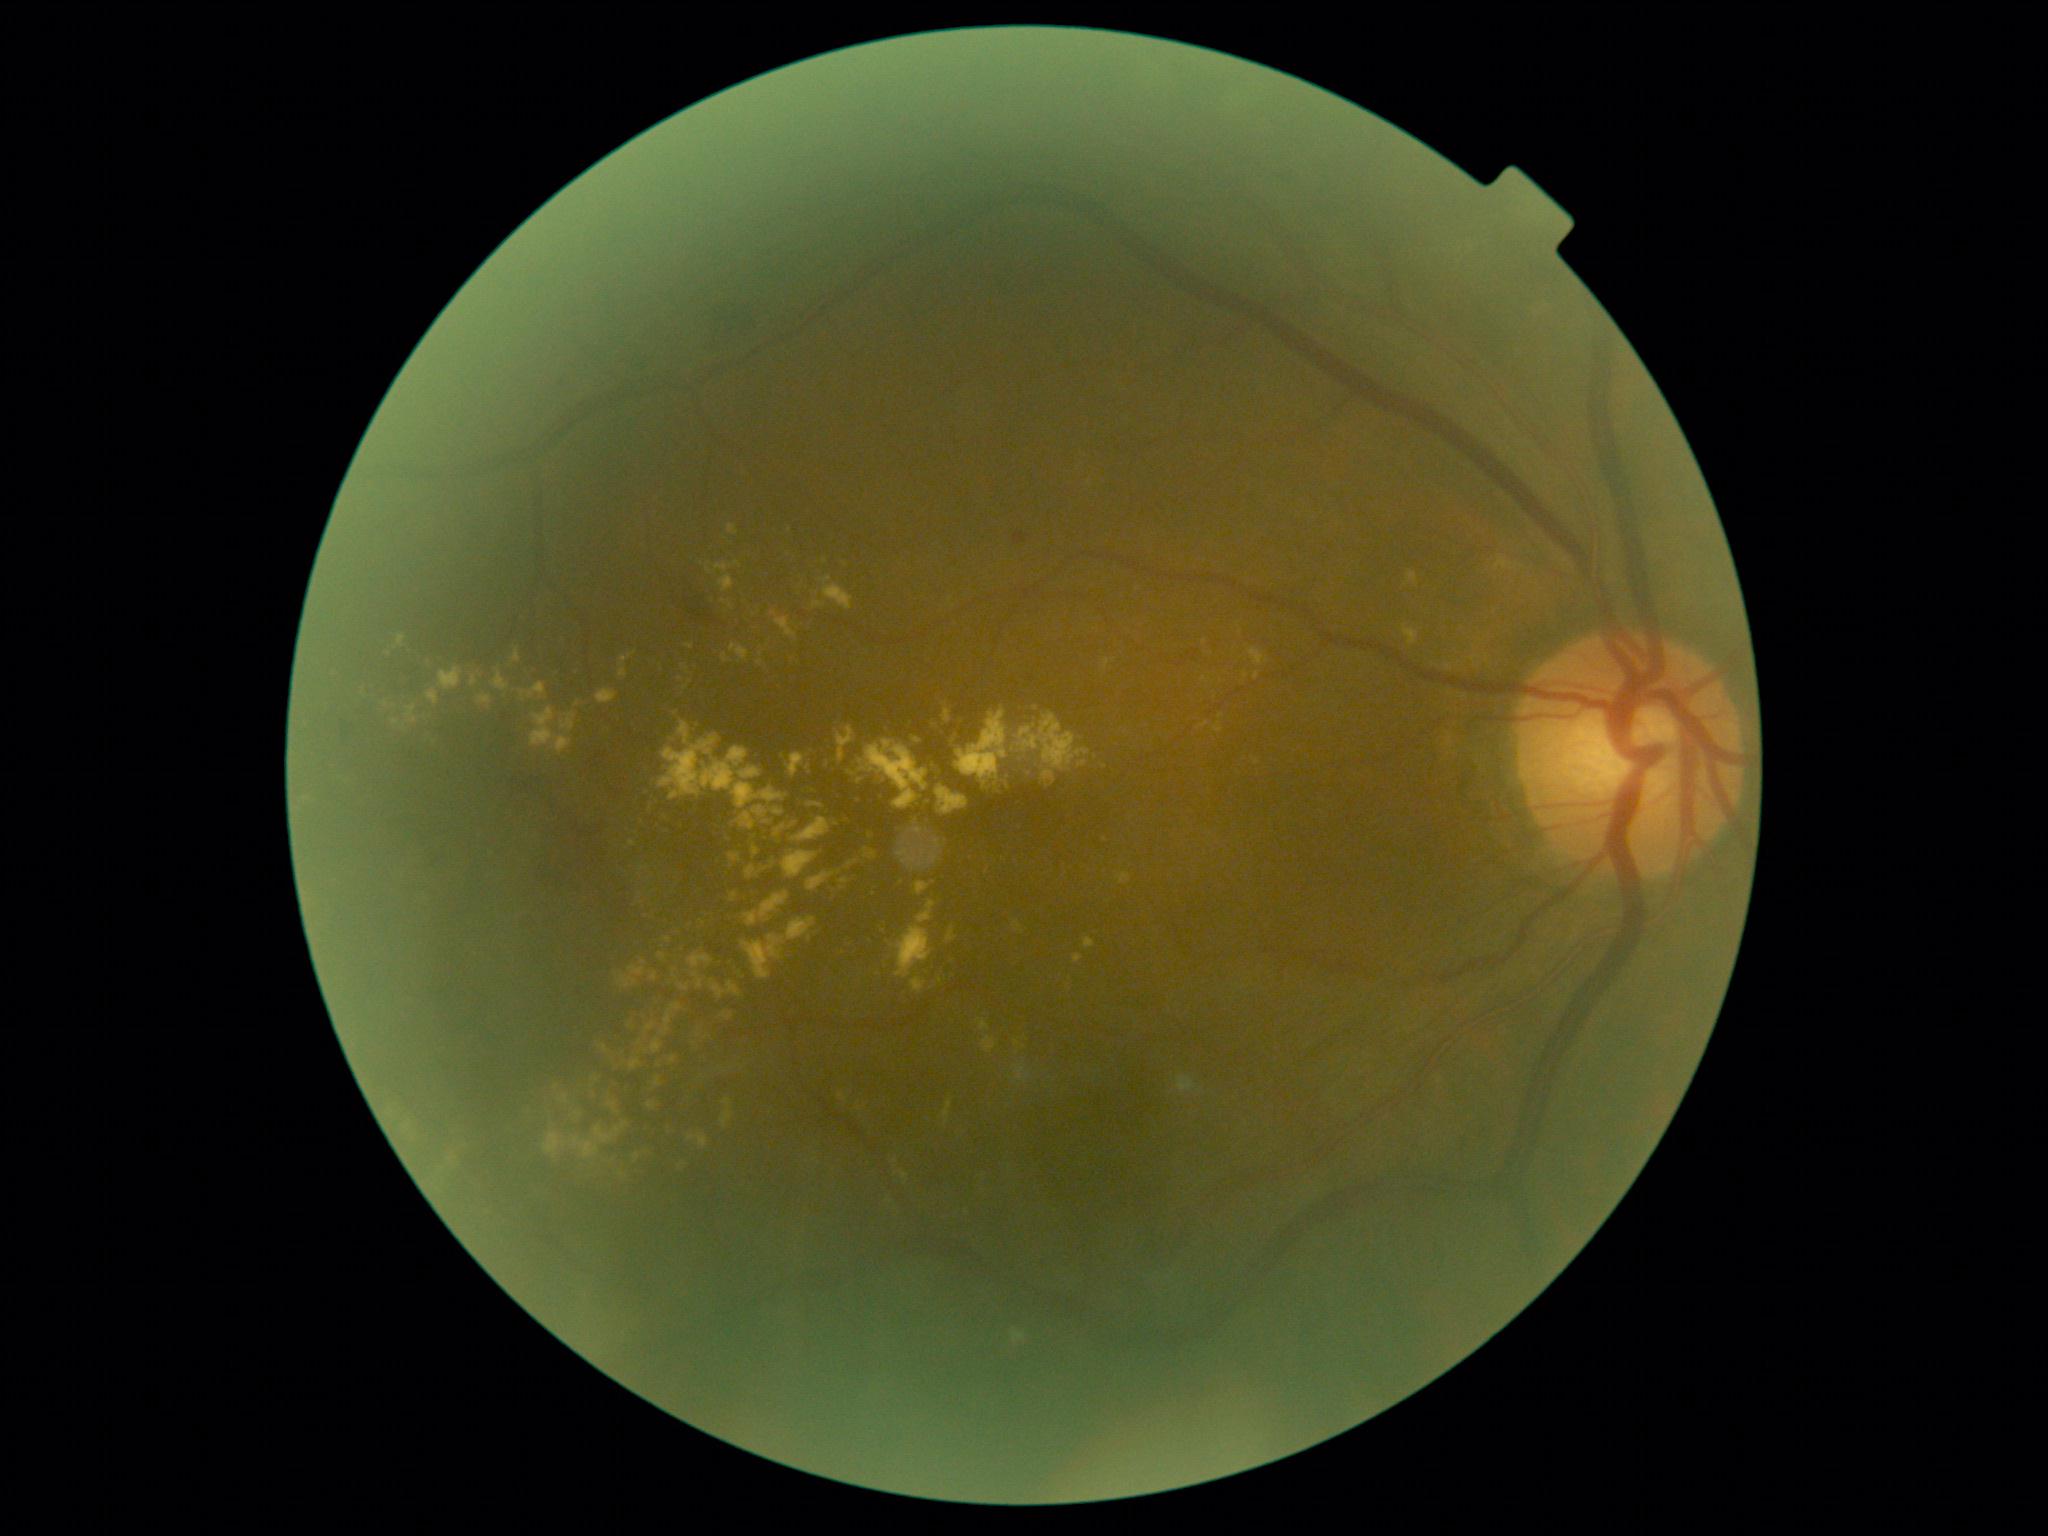 {"dr_grade": "moderate NPDR (grade 2)", "dr_category": "non-proliferative diabetic retinopathy"}